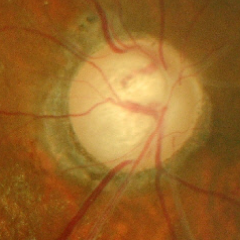

Color fundus photograph showing advanced-stage glaucoma.